45° FOV; 2212x1659 — 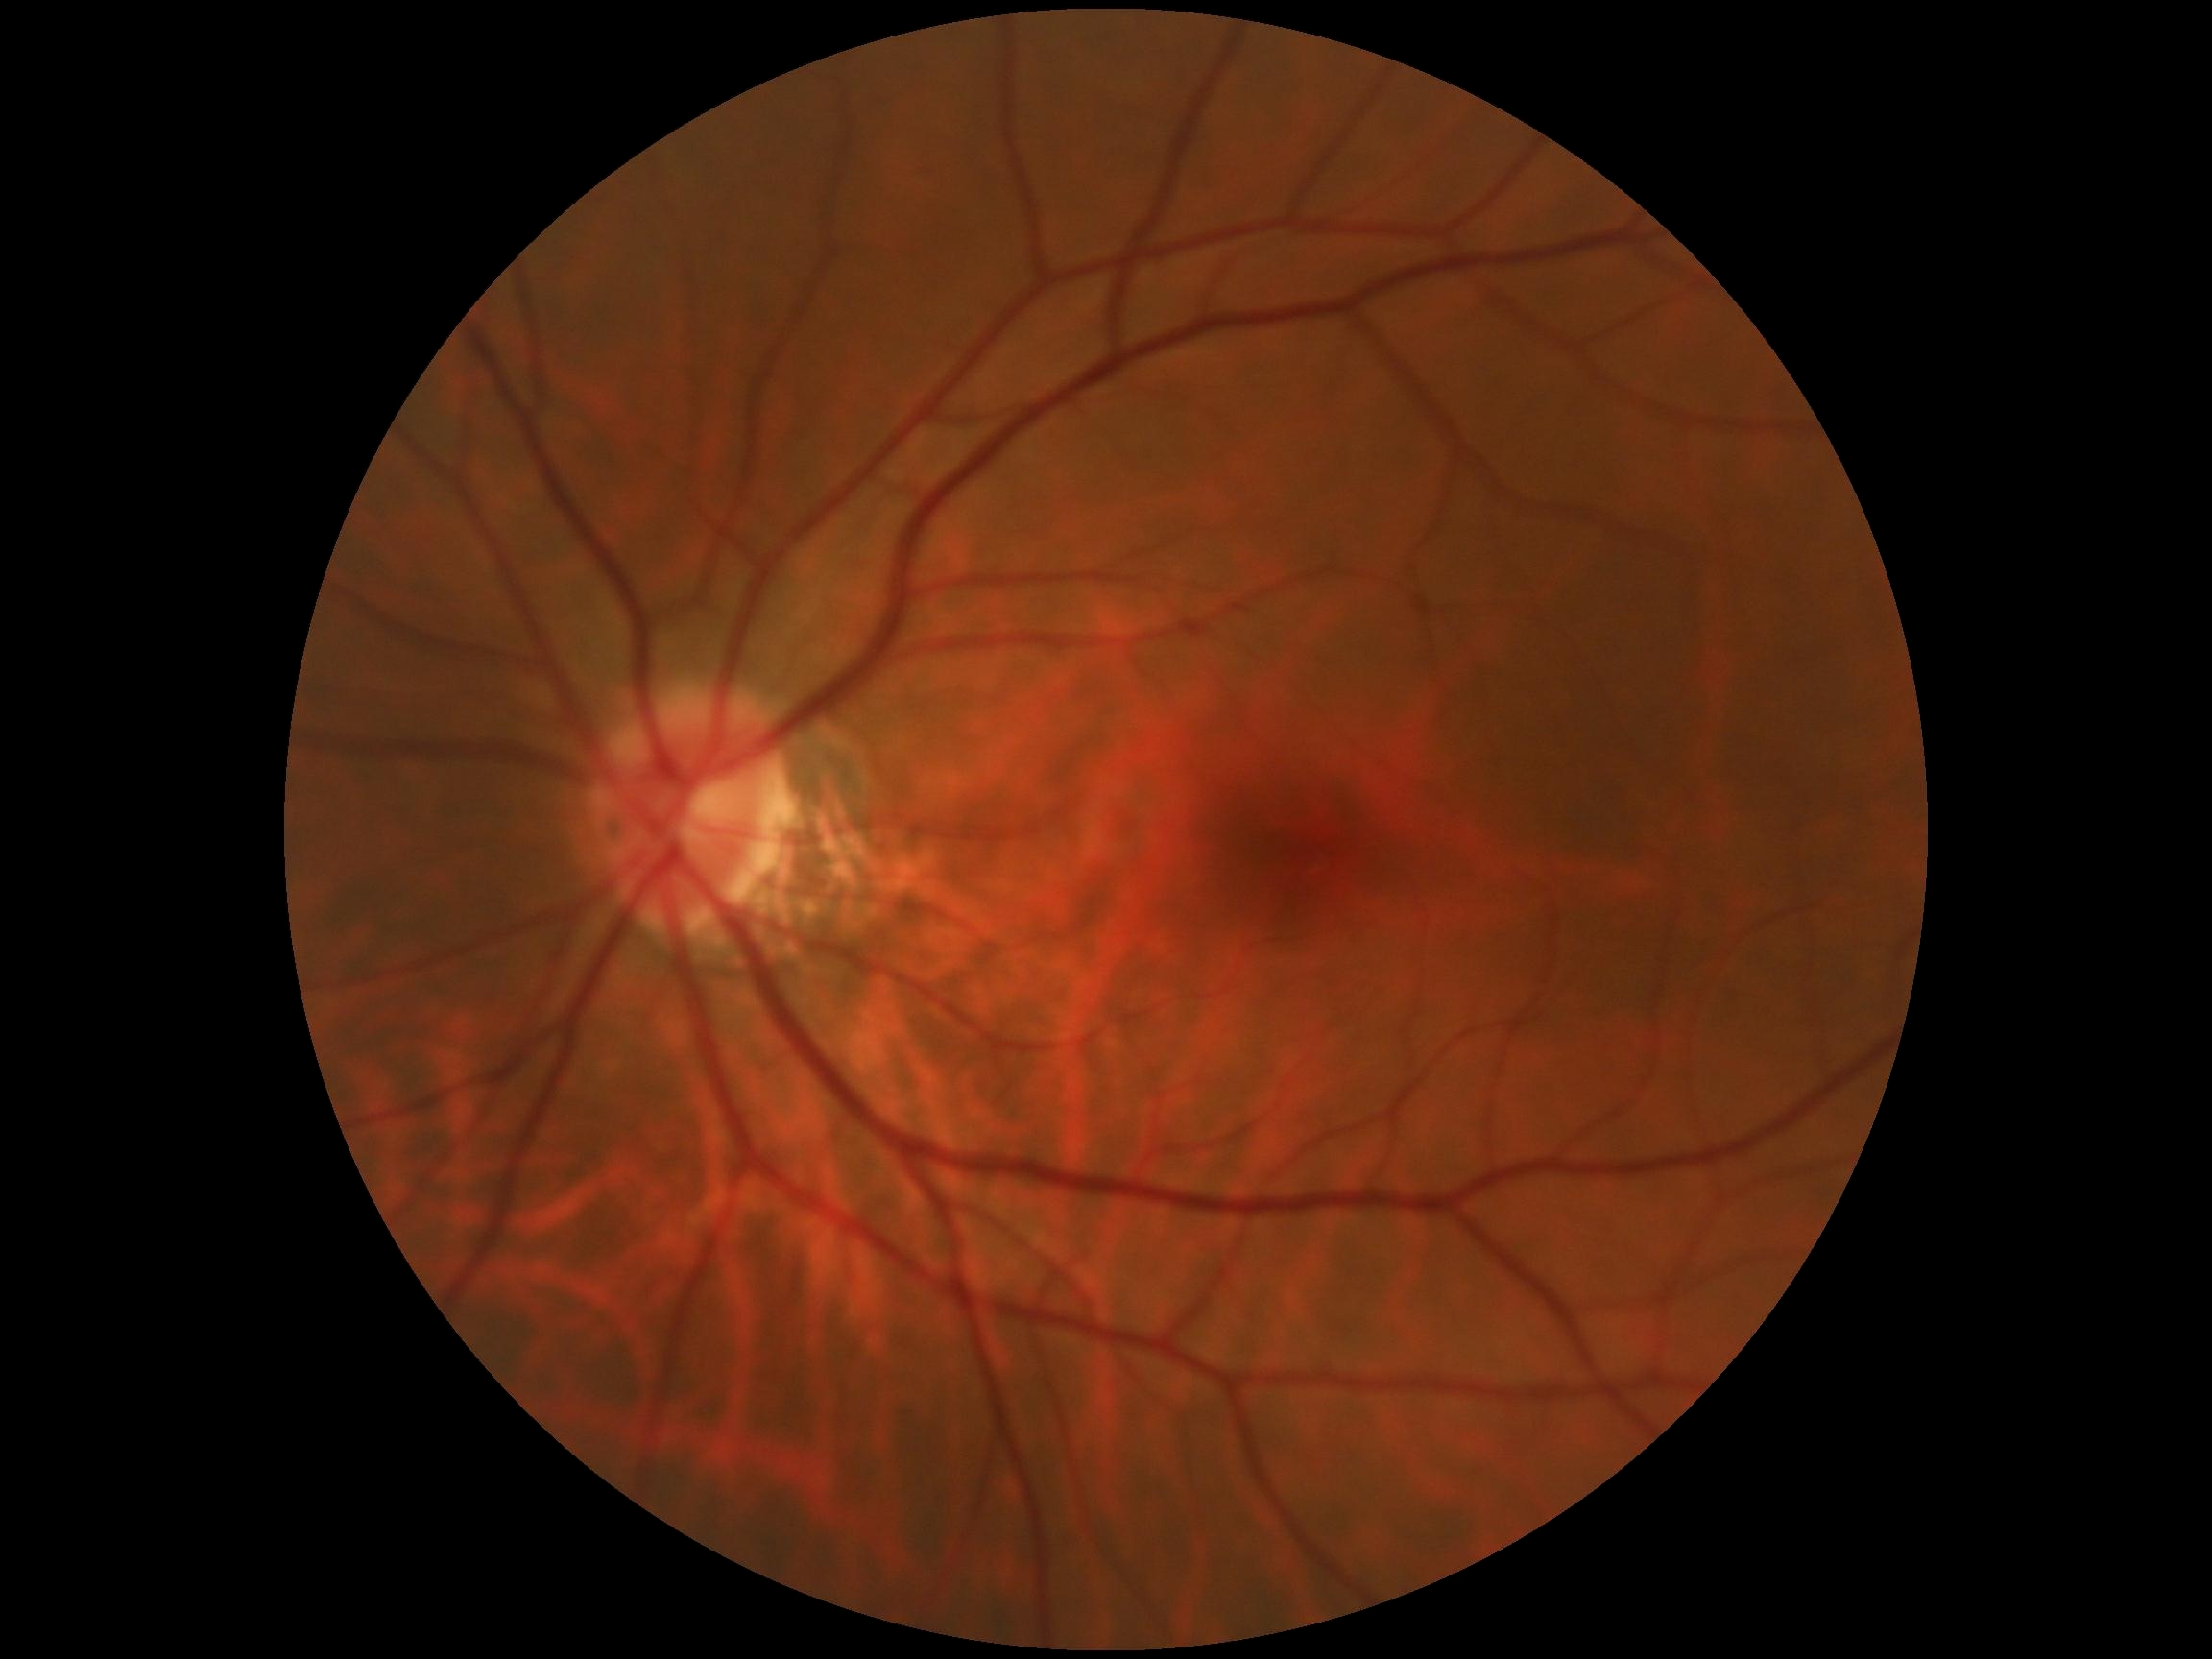

DR impression: no apparent DR | DR grade: 0 (no apparent retinopathy).